CFP; 1932 x 1916 pixels.
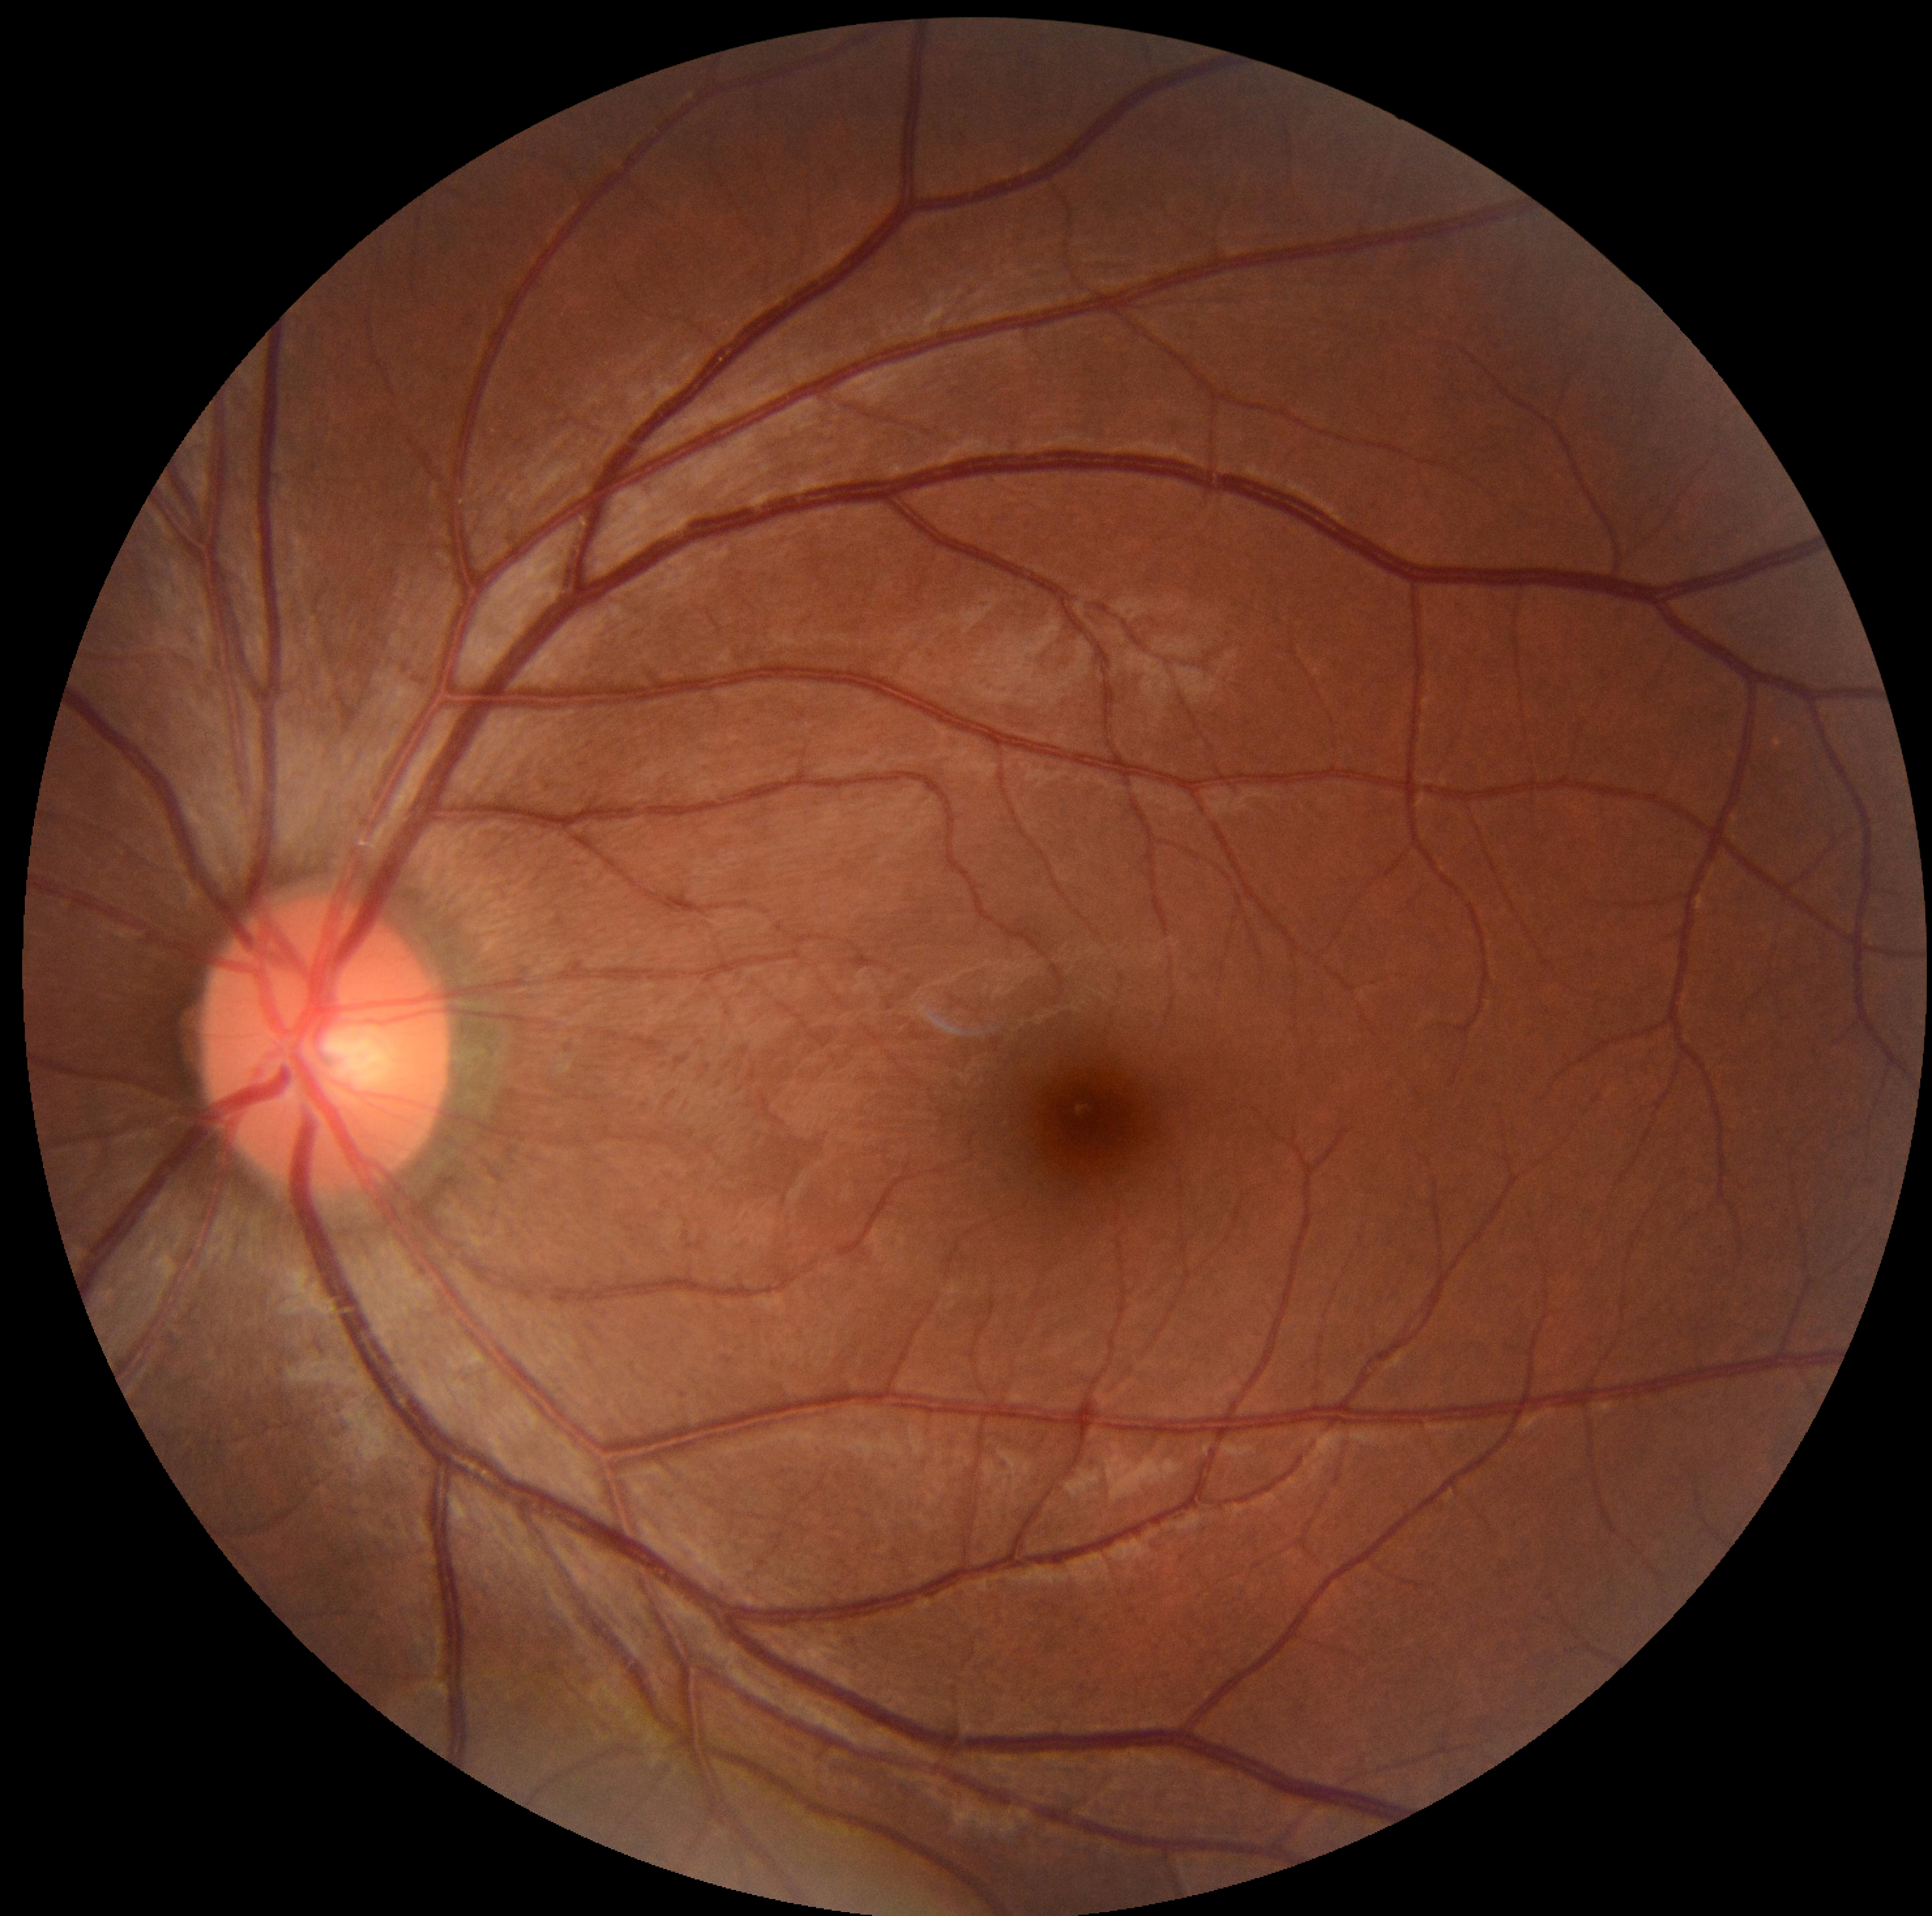

DR is no apparent diabetic retinopathy (grade 0) — no visible signs of diabetic retinopathy.